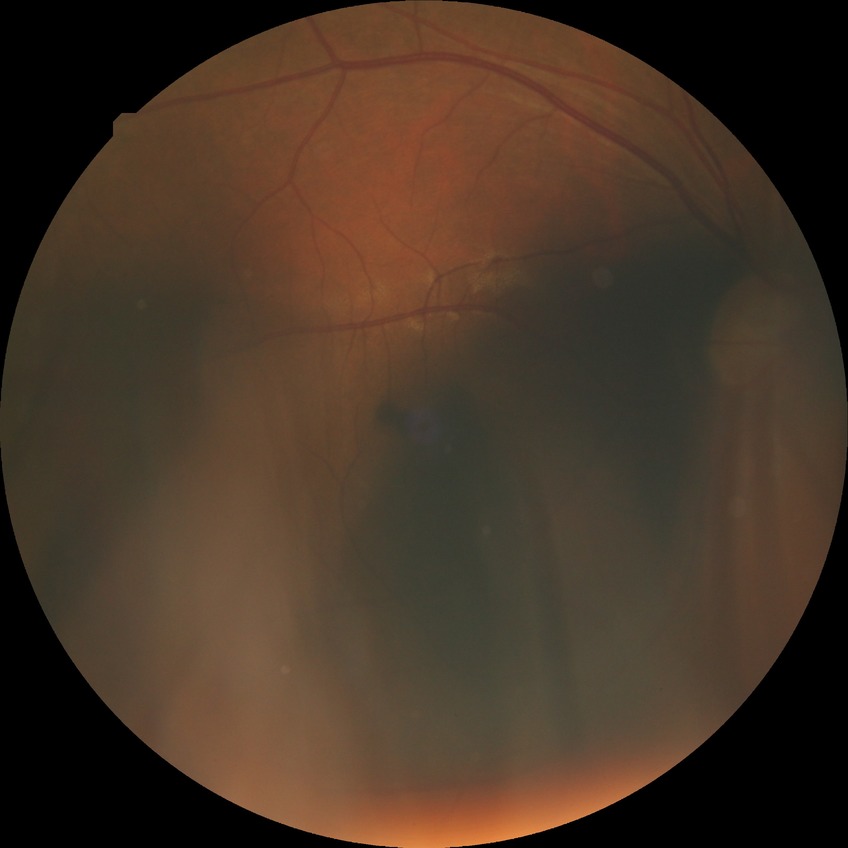
Diabetic retinopathy (DR) is SDR (simple diabetic retinopathy).
The retinopathy is classified as non-proliferative diabetic retinopathy.